Infant wide-field retinal image · acquired on the Phoenix ICON
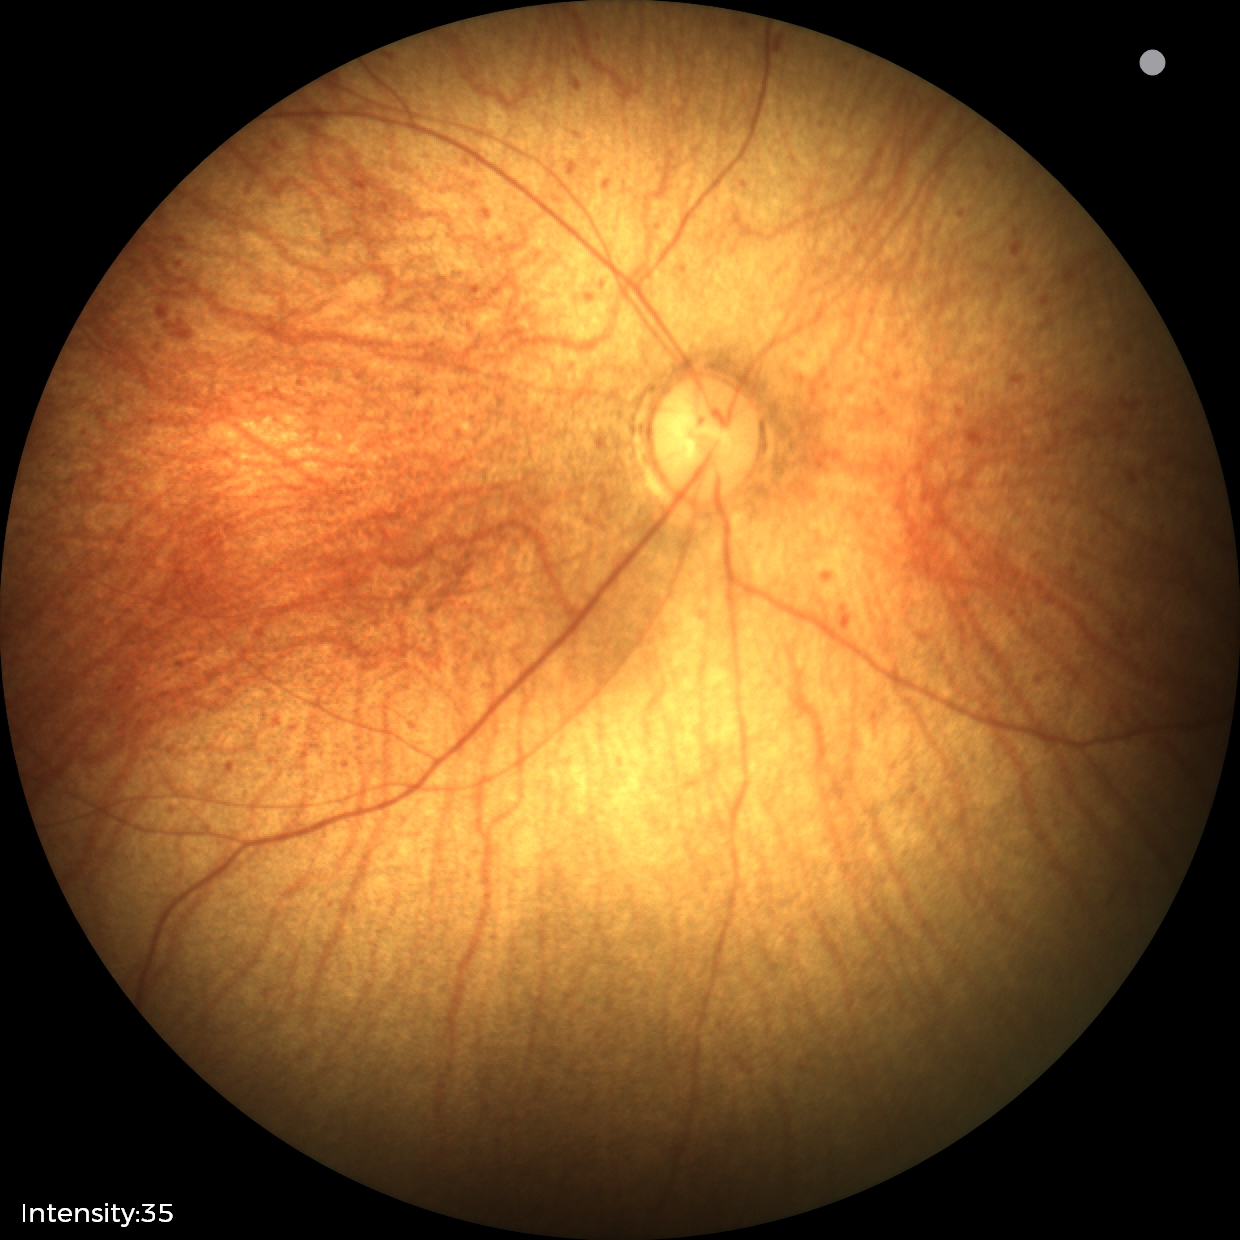

Screening examination with no abnormal retinal findings.